Image size 1932x1916; 45-degree field of view; color fundus photograph — 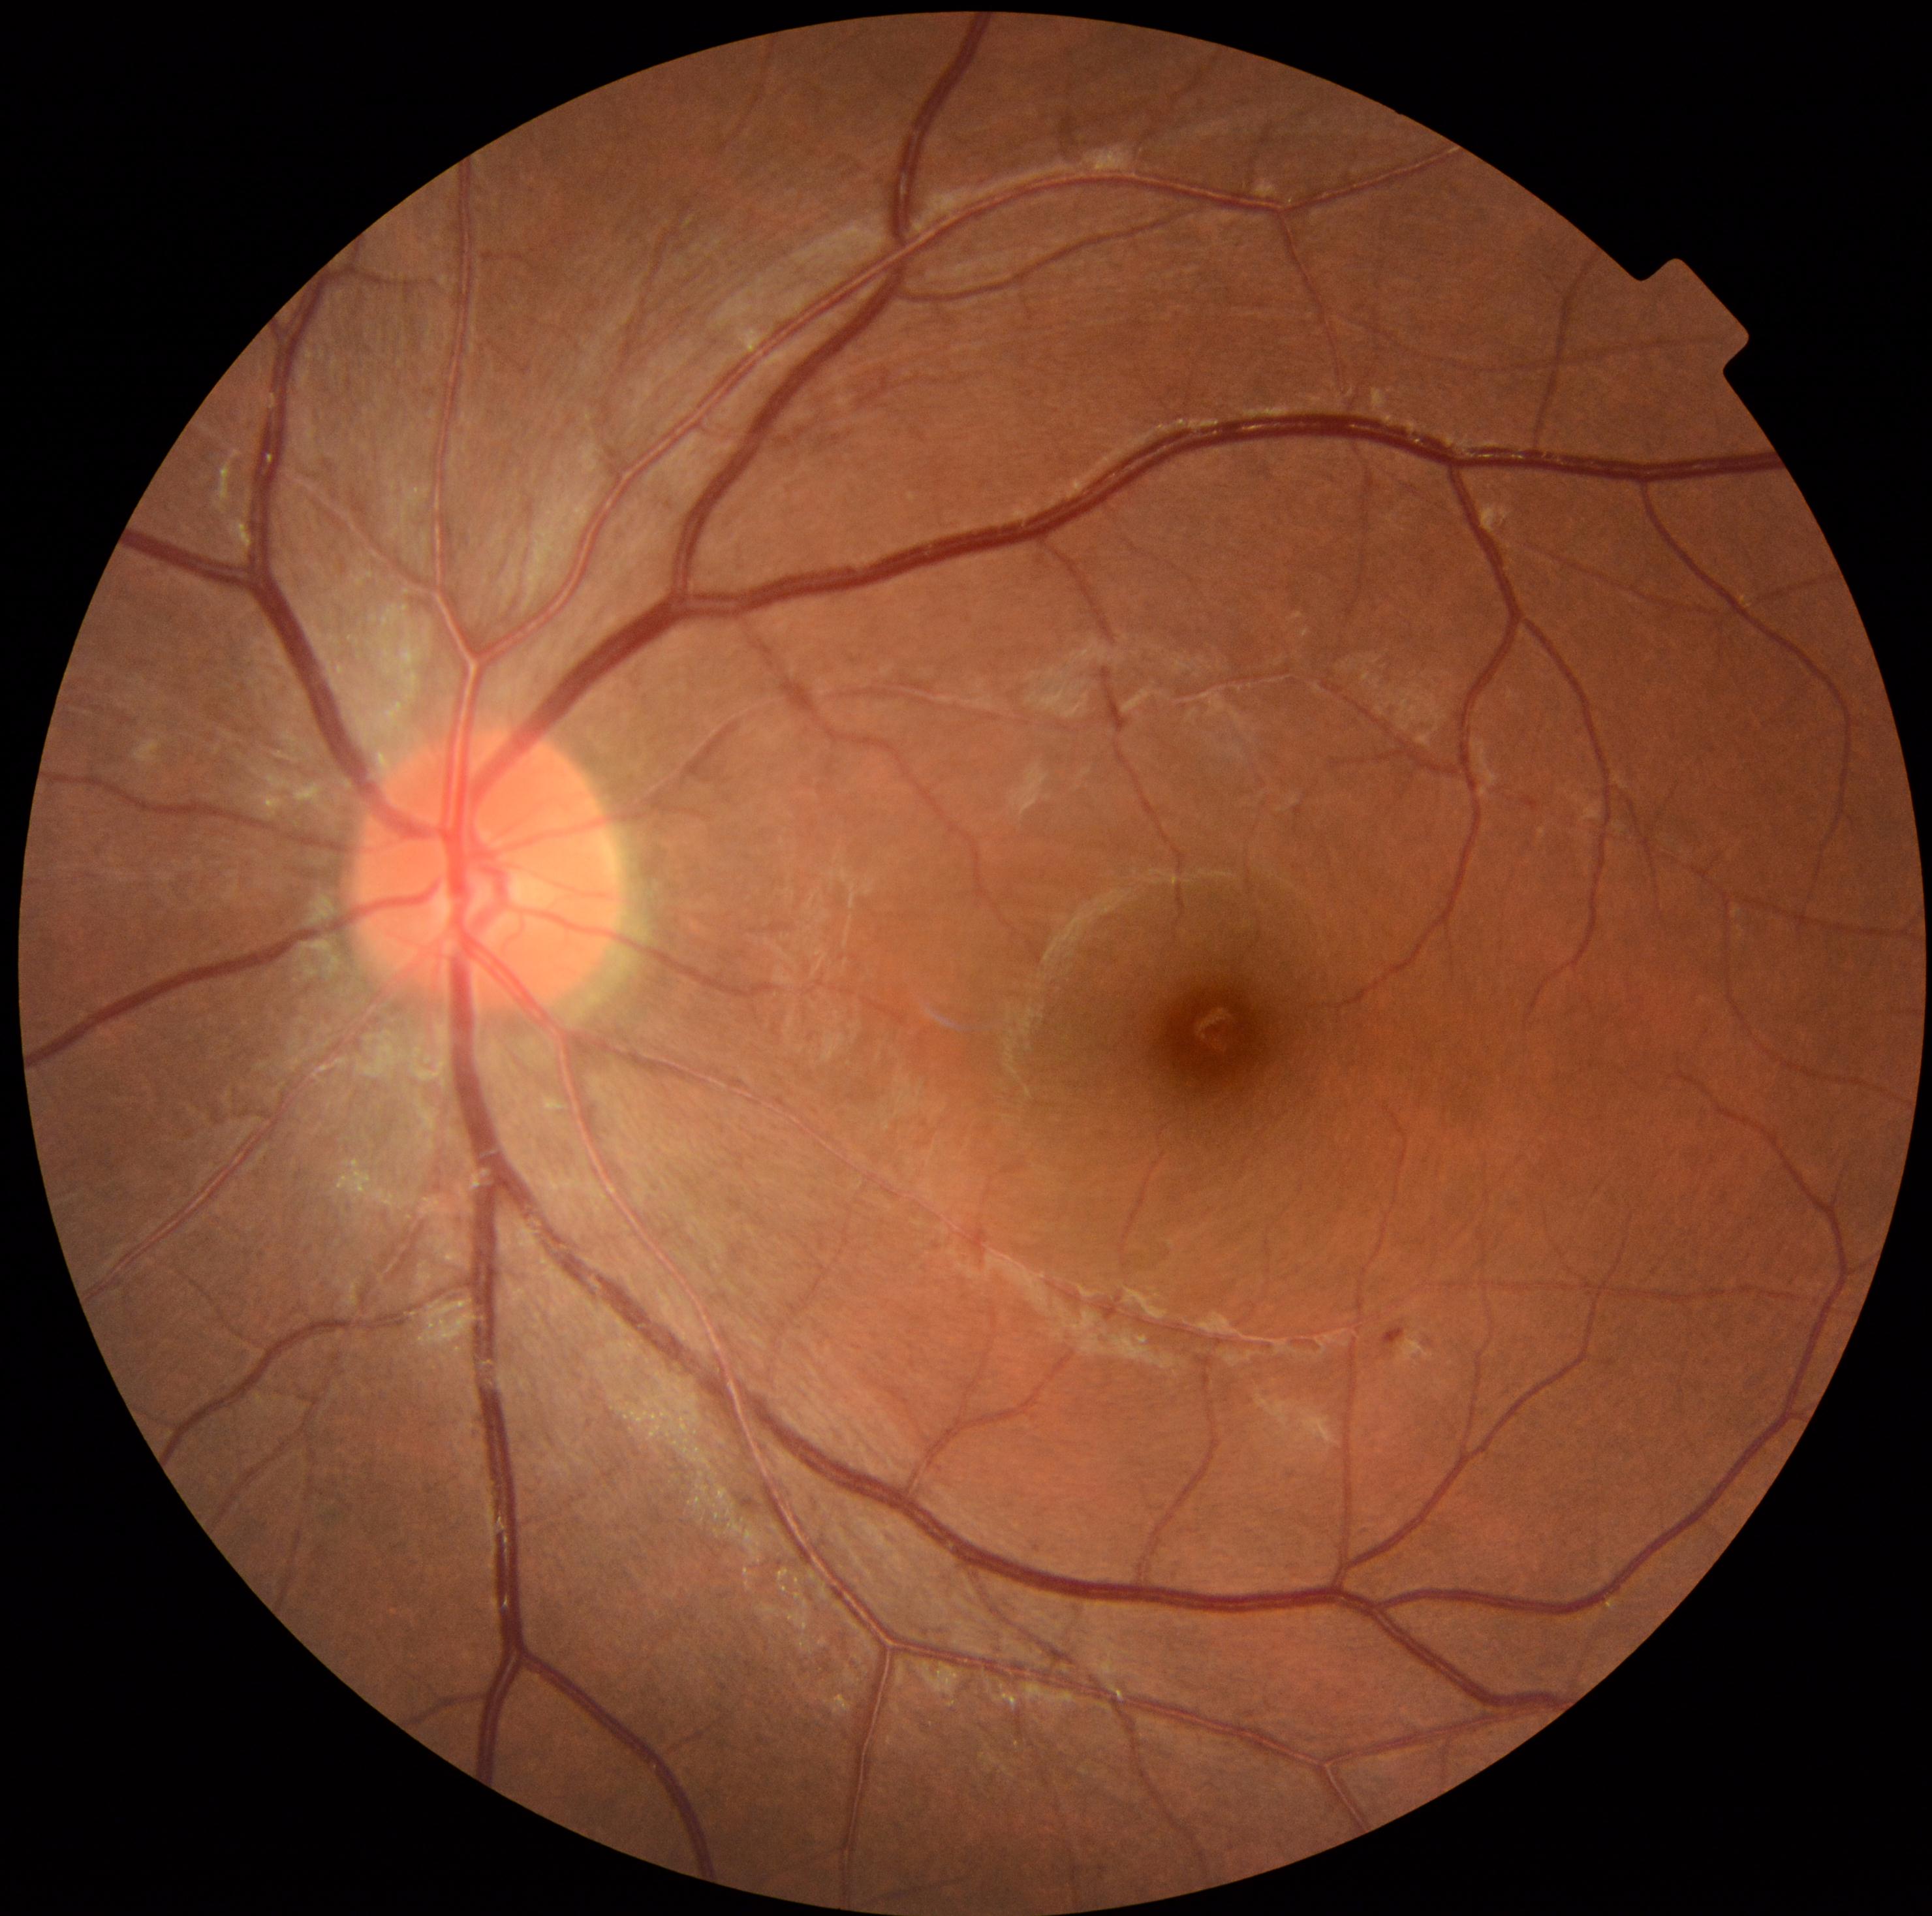

Annotations:
* DR — 1 — presence of microaneurysms only
* DR class — non-proliferative diabetic retinopathy